1659 by 2212 pixels · acquired with a Remidio Fundus on Phone (FOP) camera · color fundus image: 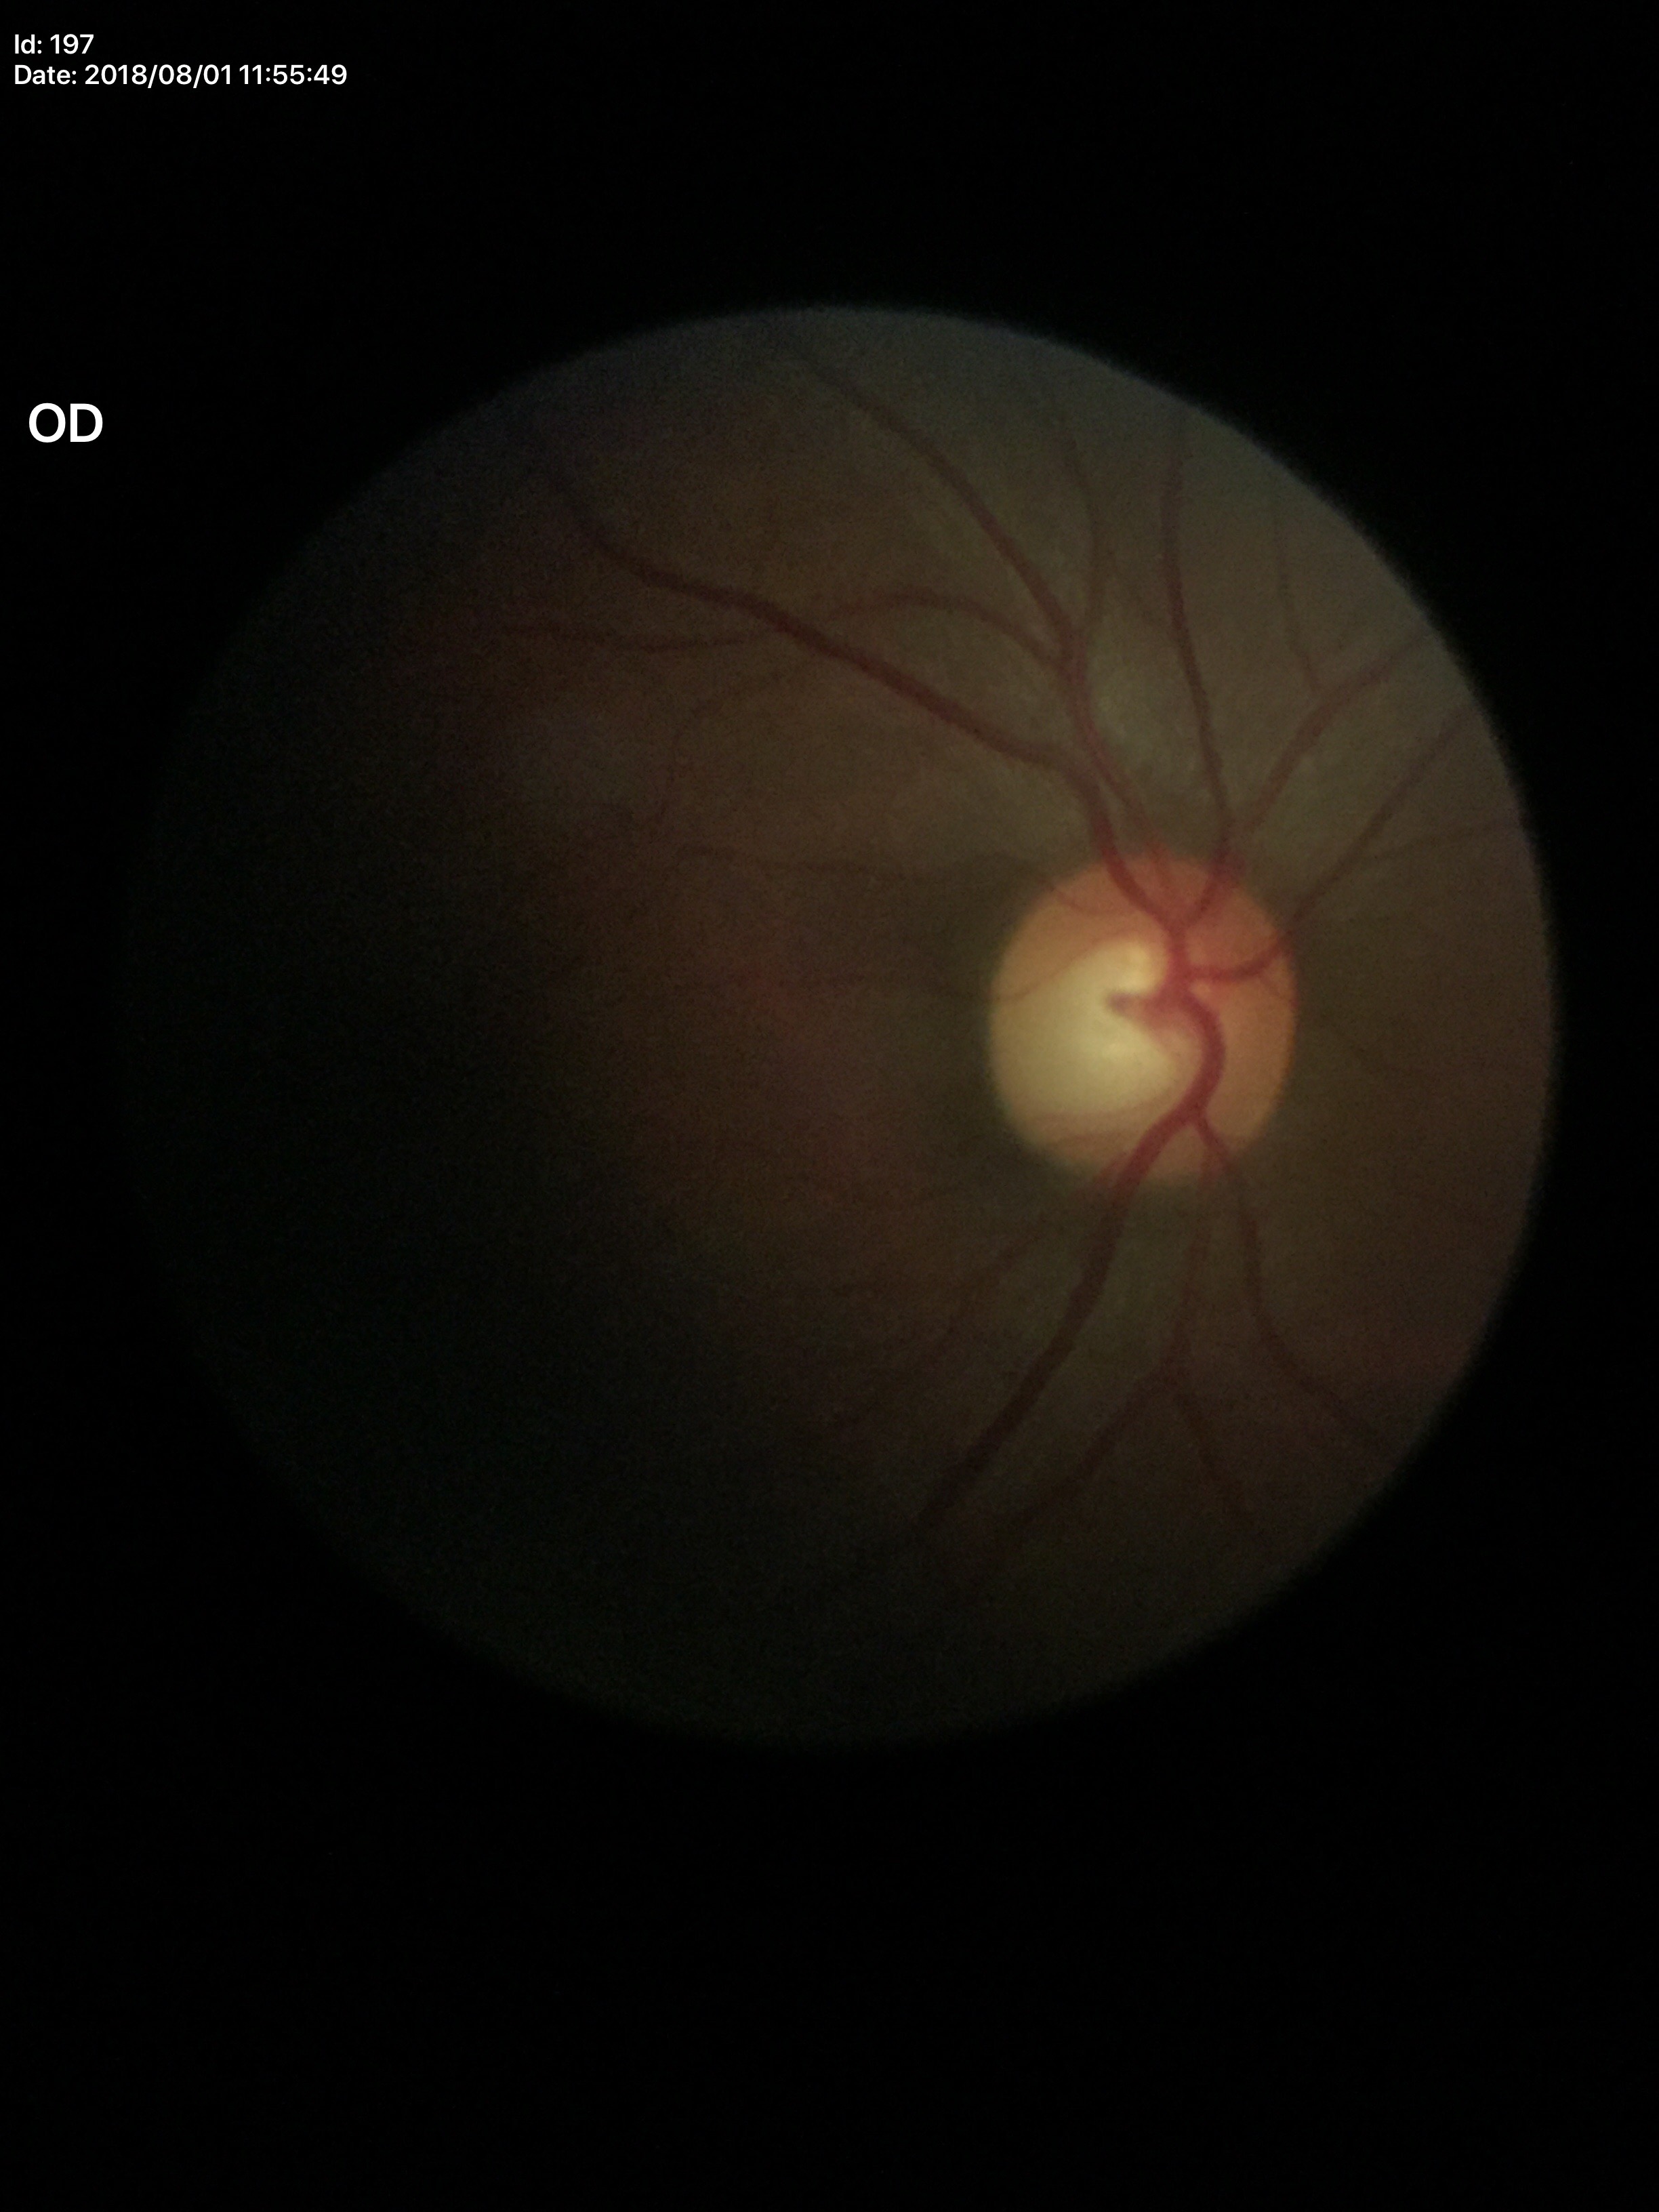 Glaucoma impression = no suspicious findings
VCDR = 0.56